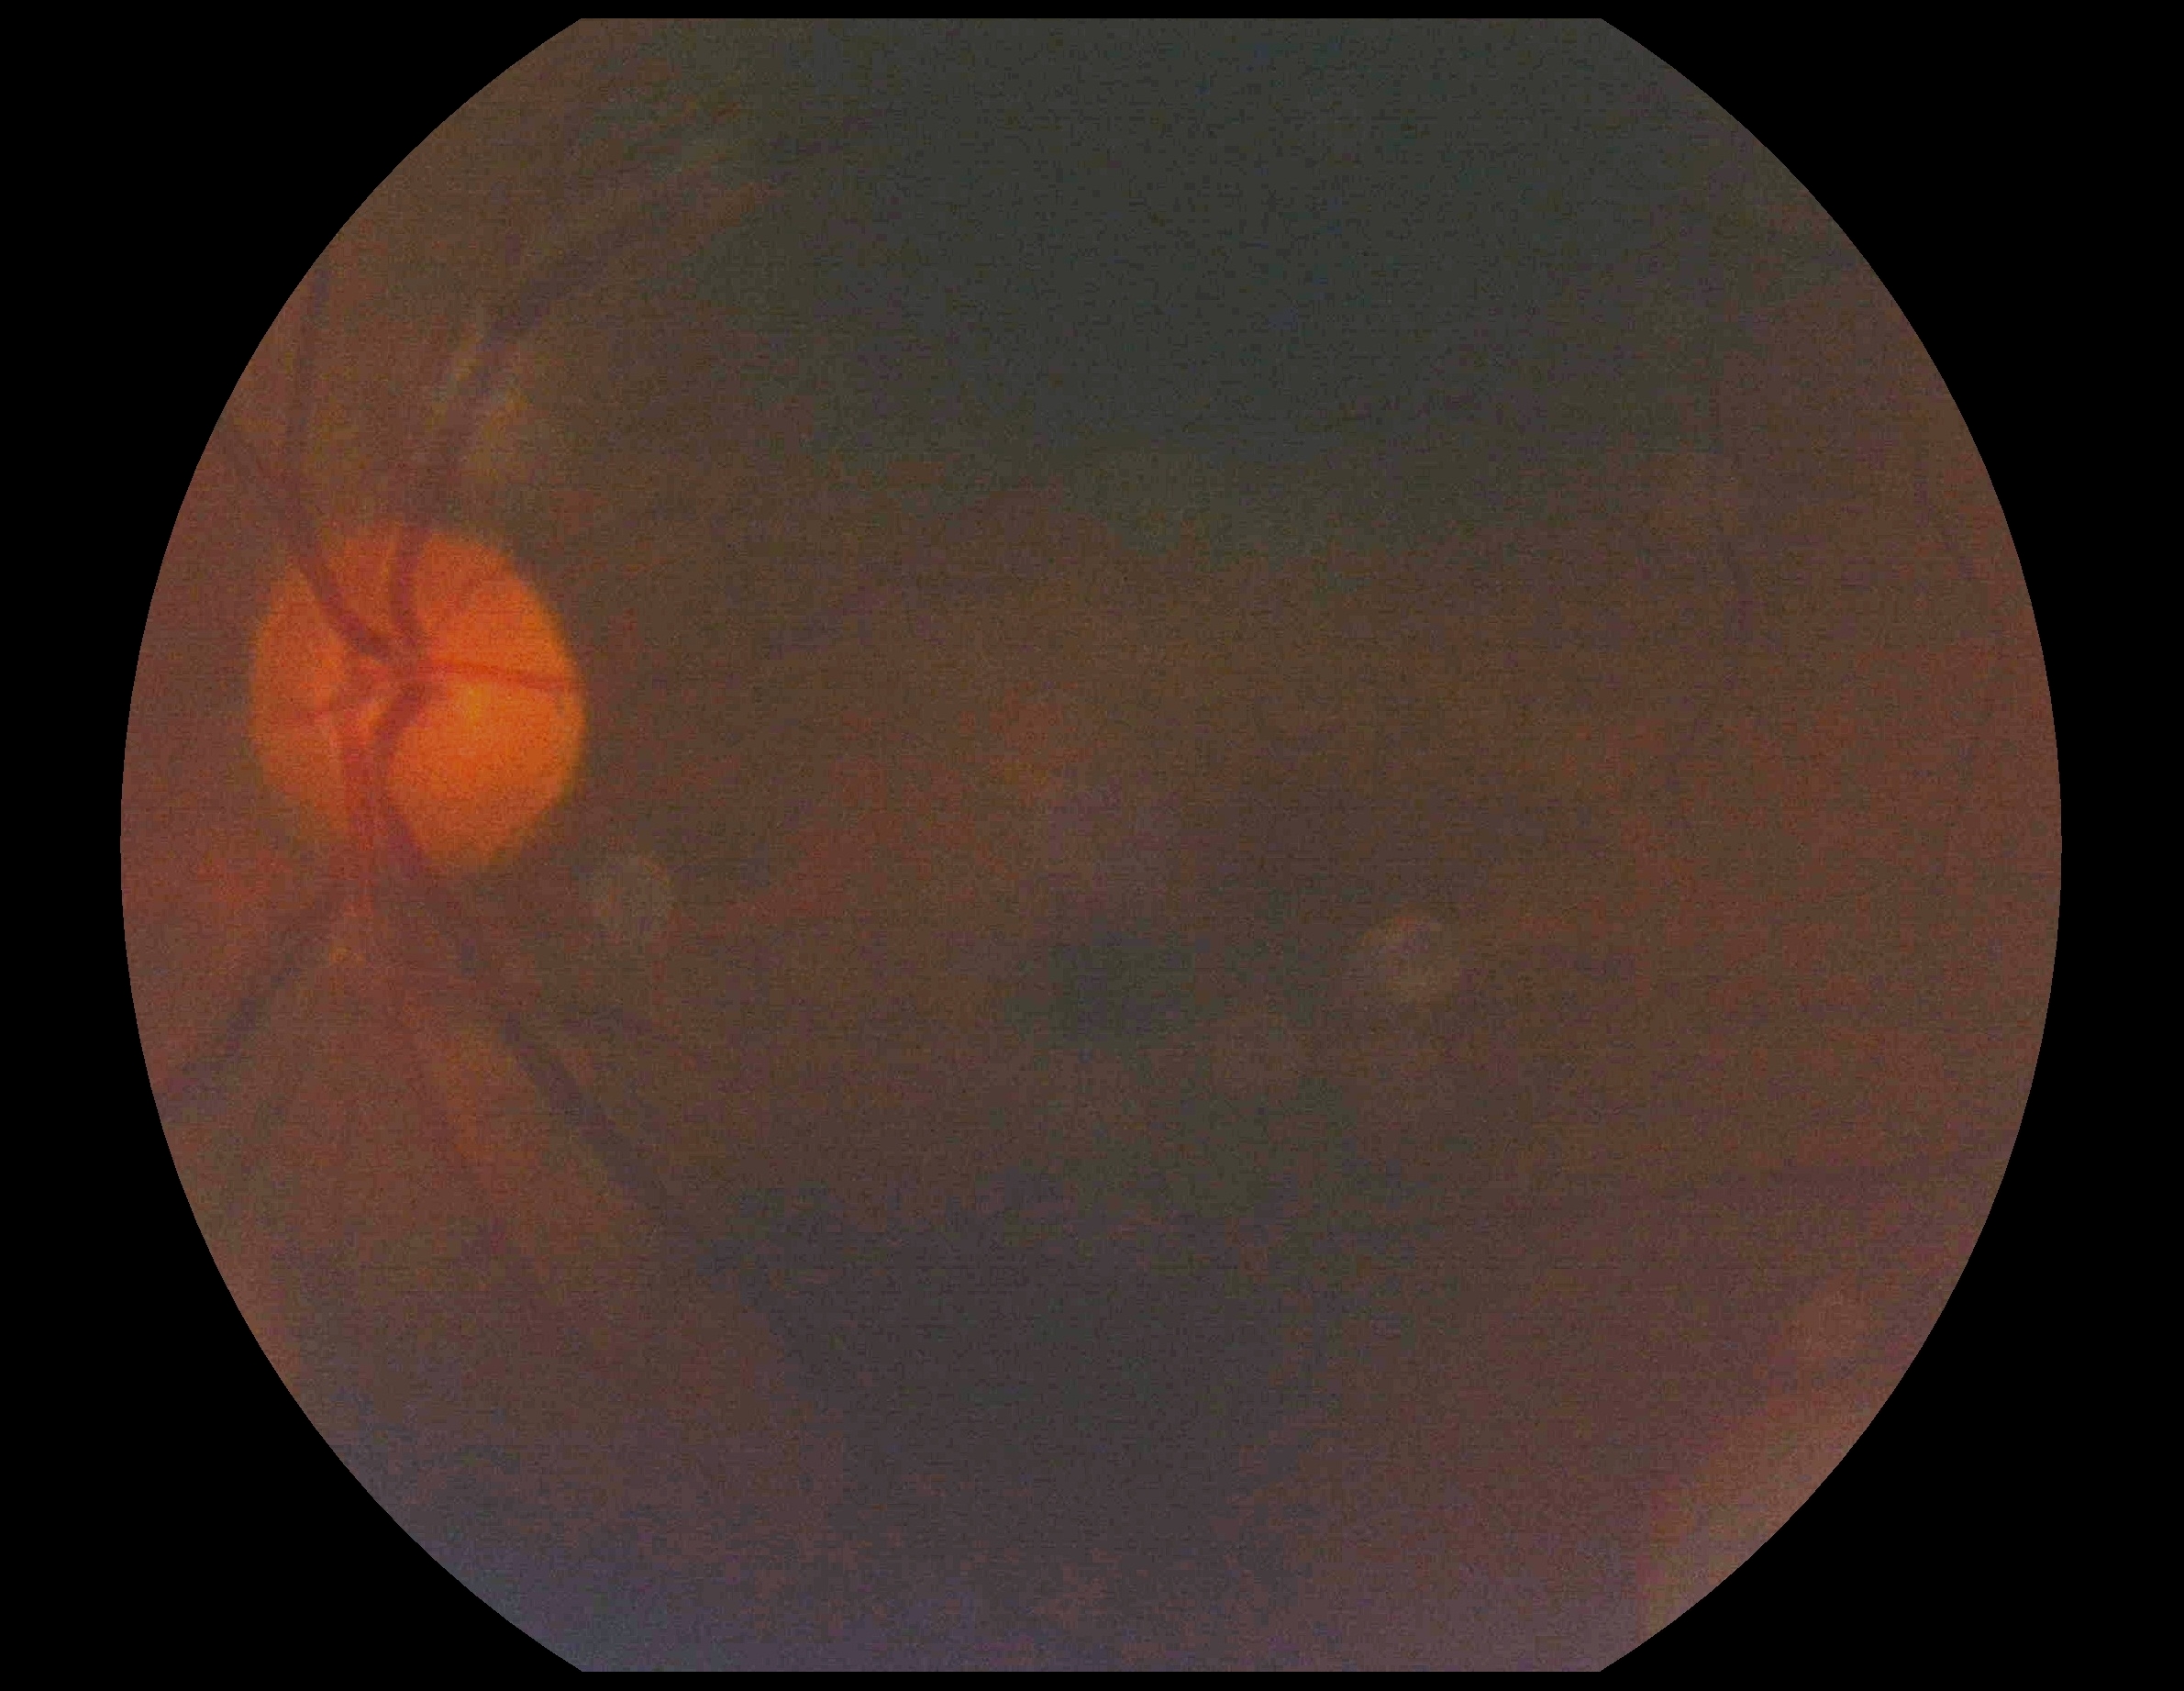
{"dr_grade": "ungradable", "quality": "insufficient for DR assessment"}